Davis DR grading.
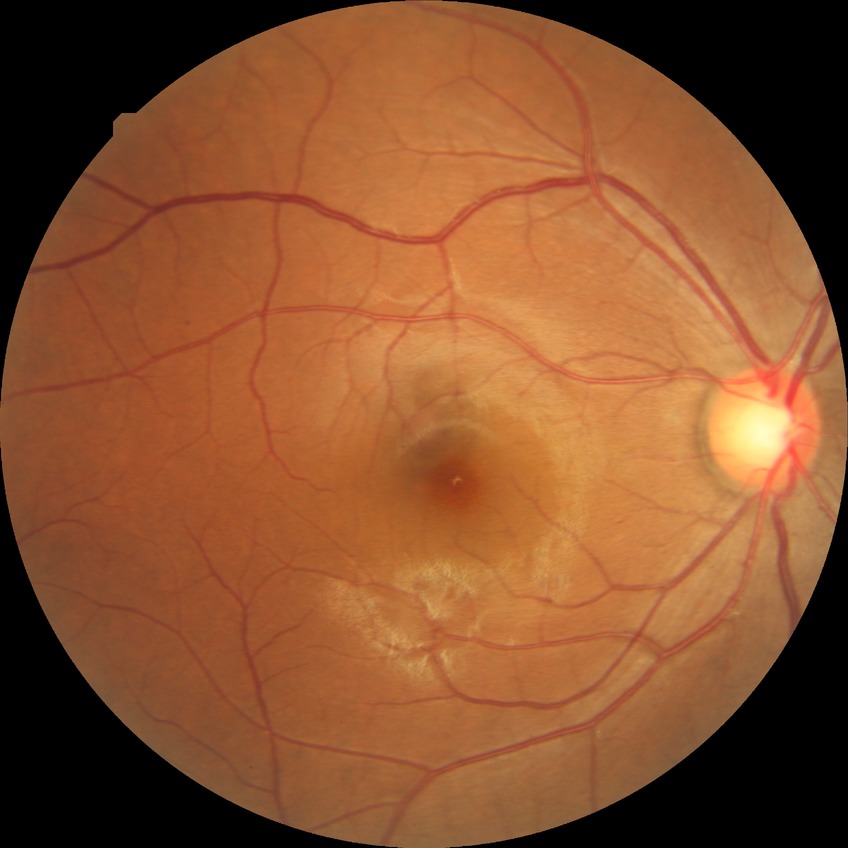 Retinopathy grade is simple diabetic retinopathy.